Nonmydriatic; retinal fundus photograph.
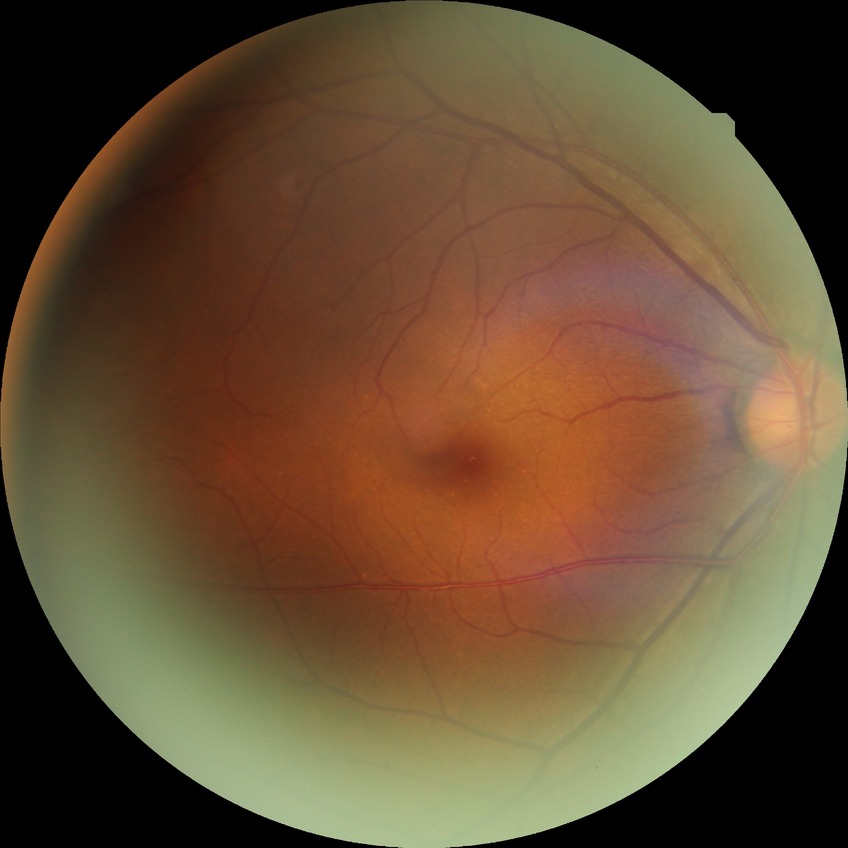
Diabetic retinopathy (DR) is no diabetic retinopathy (NDR).